FOV: 45 degrees.
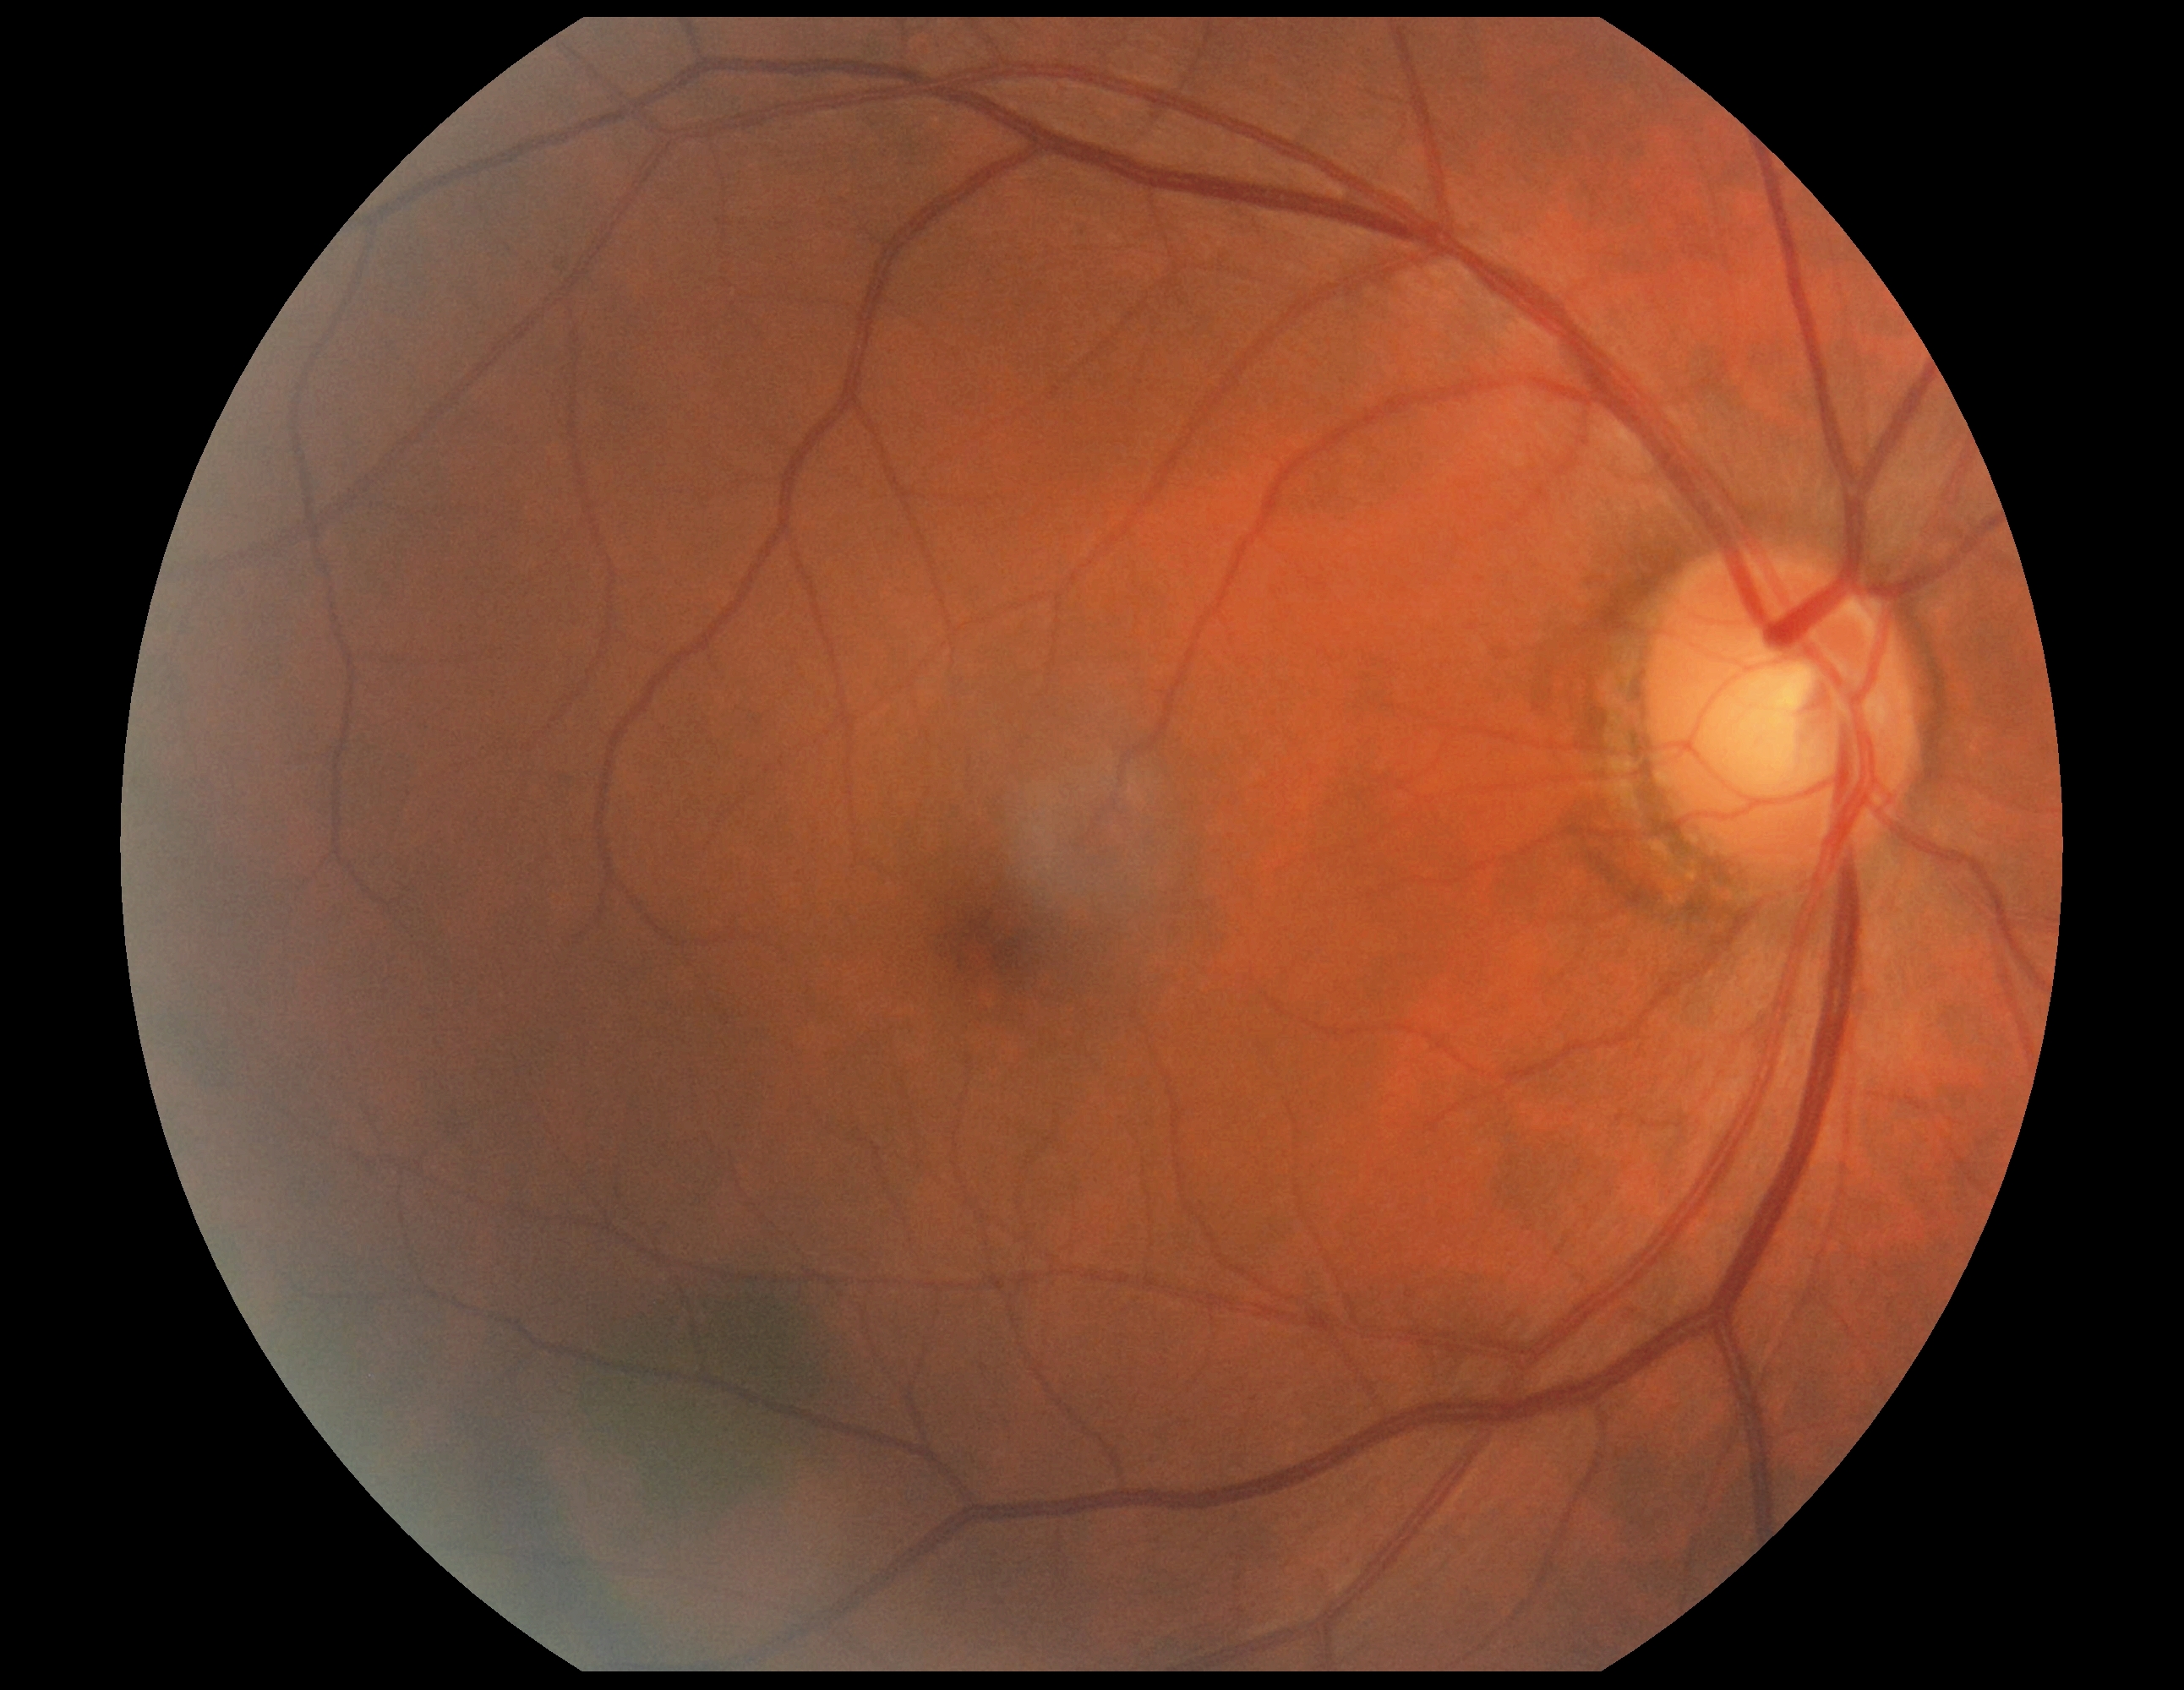
Diabetic retinopathy (DR) is grade 0.